Color fundus photograph, image size 1920x1088, FOV: 45 degrees:
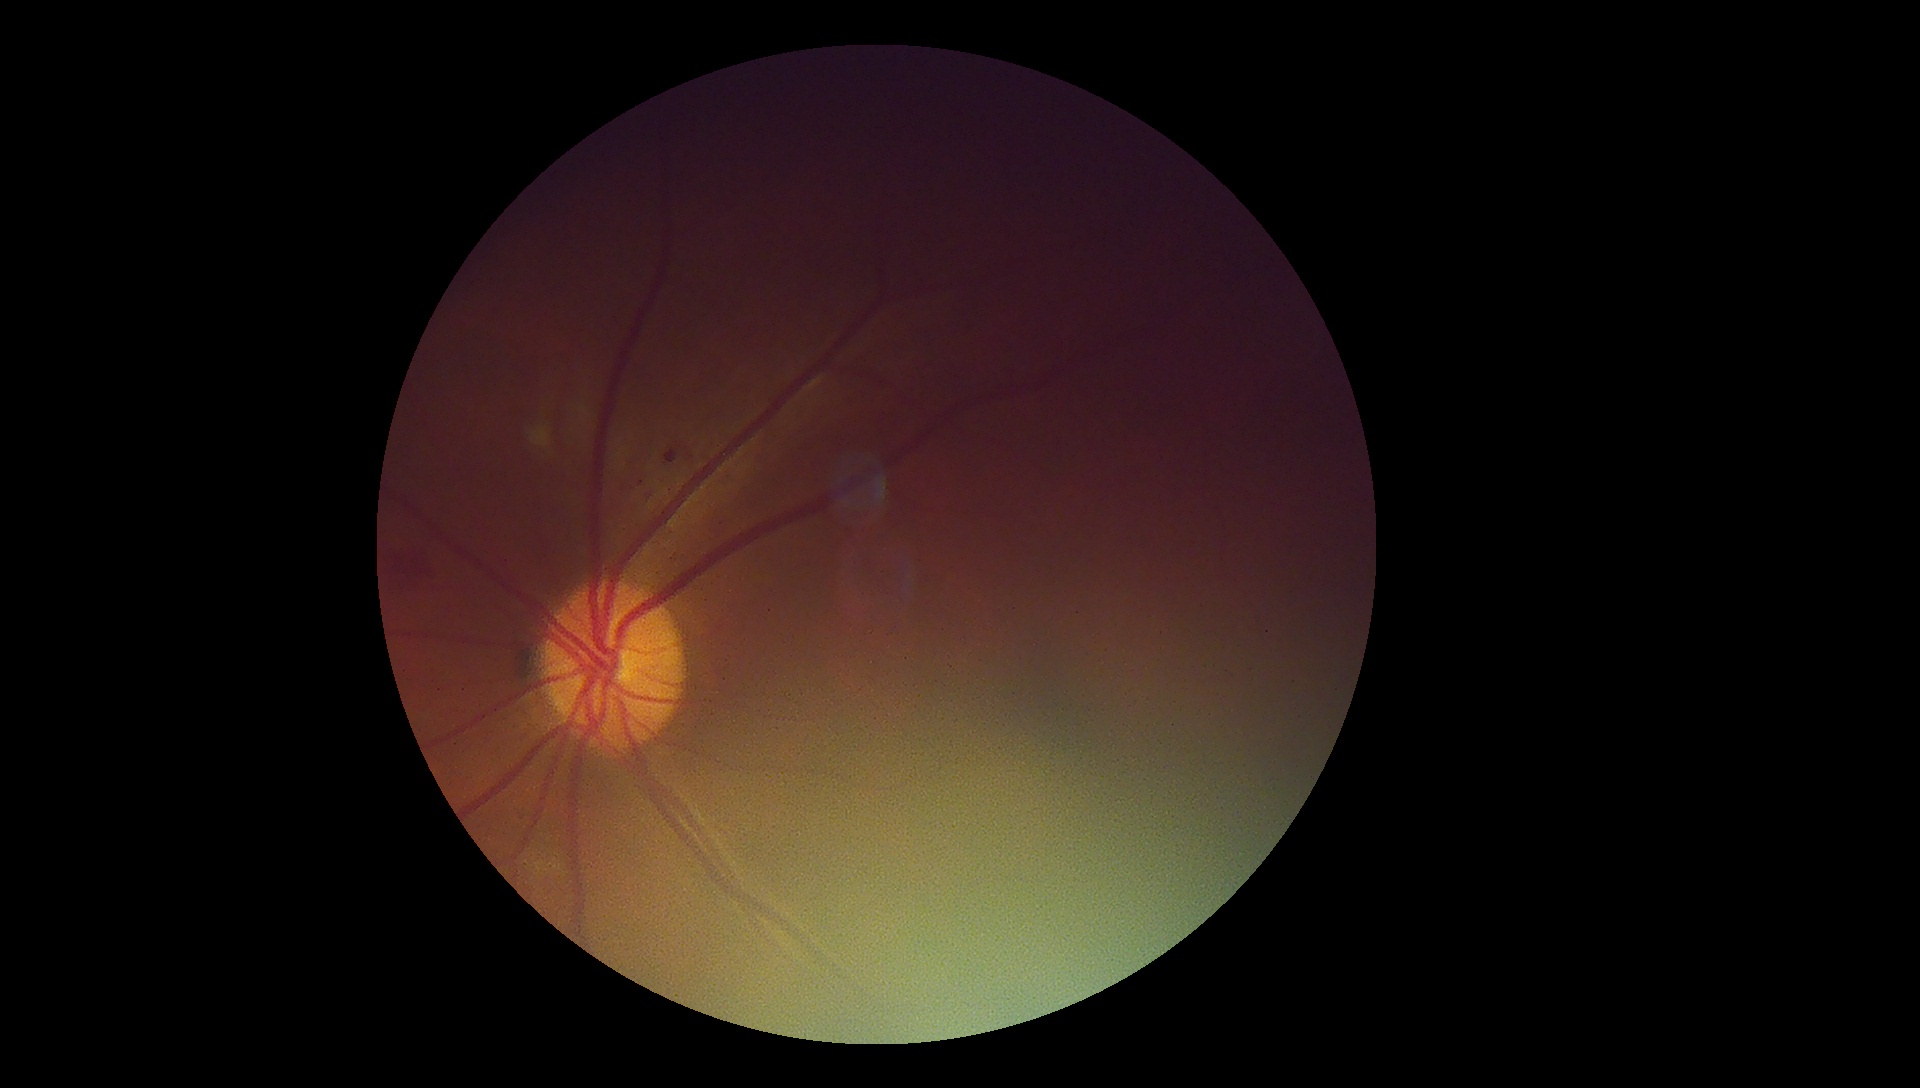 Diabetic retinopathy grade: 2 (moderate NPDR).
The retinopathy is classified as non-proliferative diabetic retinopathy.